Modified Davis classification; CFP:
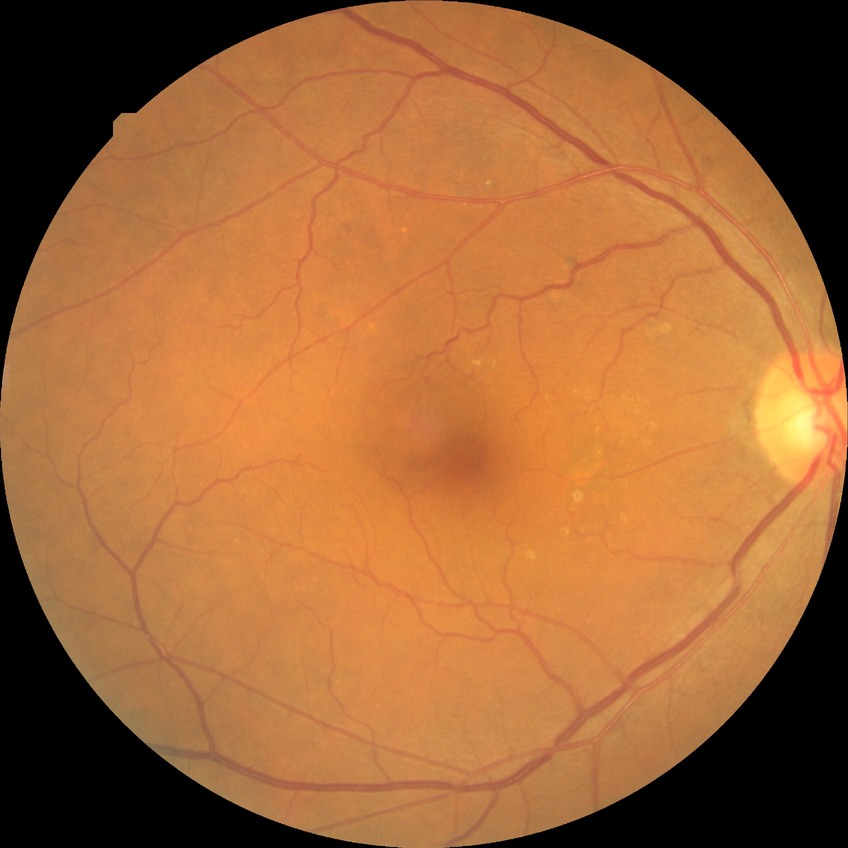 diabetic retinopathy grade: simple diabetic retinopathy.